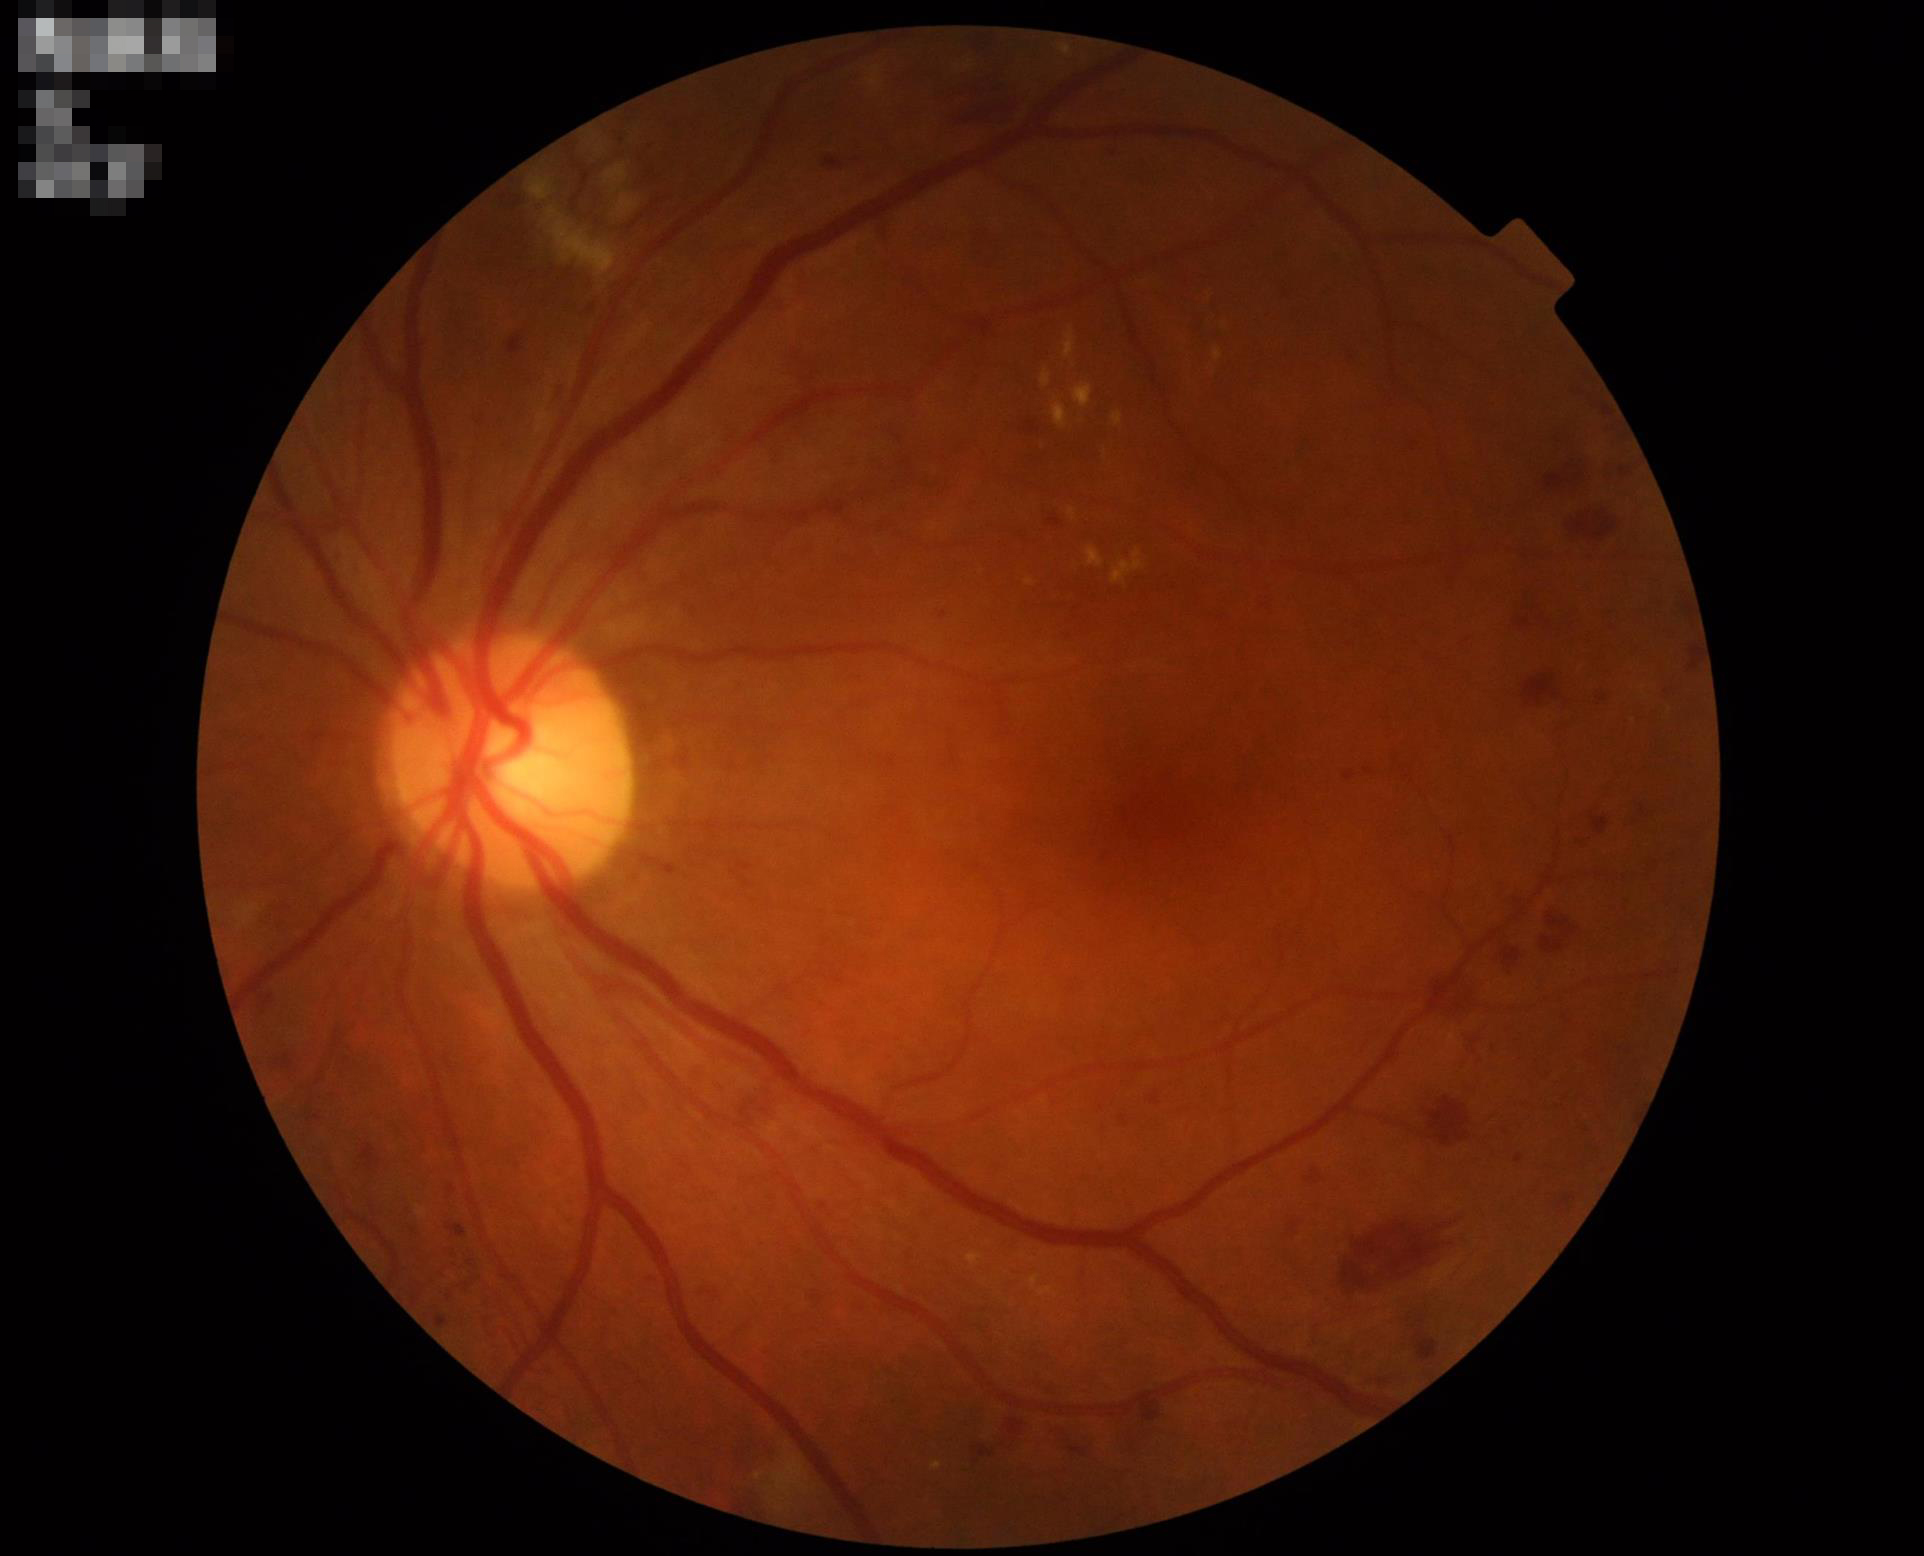

{"illumination": "adequate", "clarity": "sharp", "contrast": "satisfactory"}